Portable fundus camera image, image size 2212x1659.
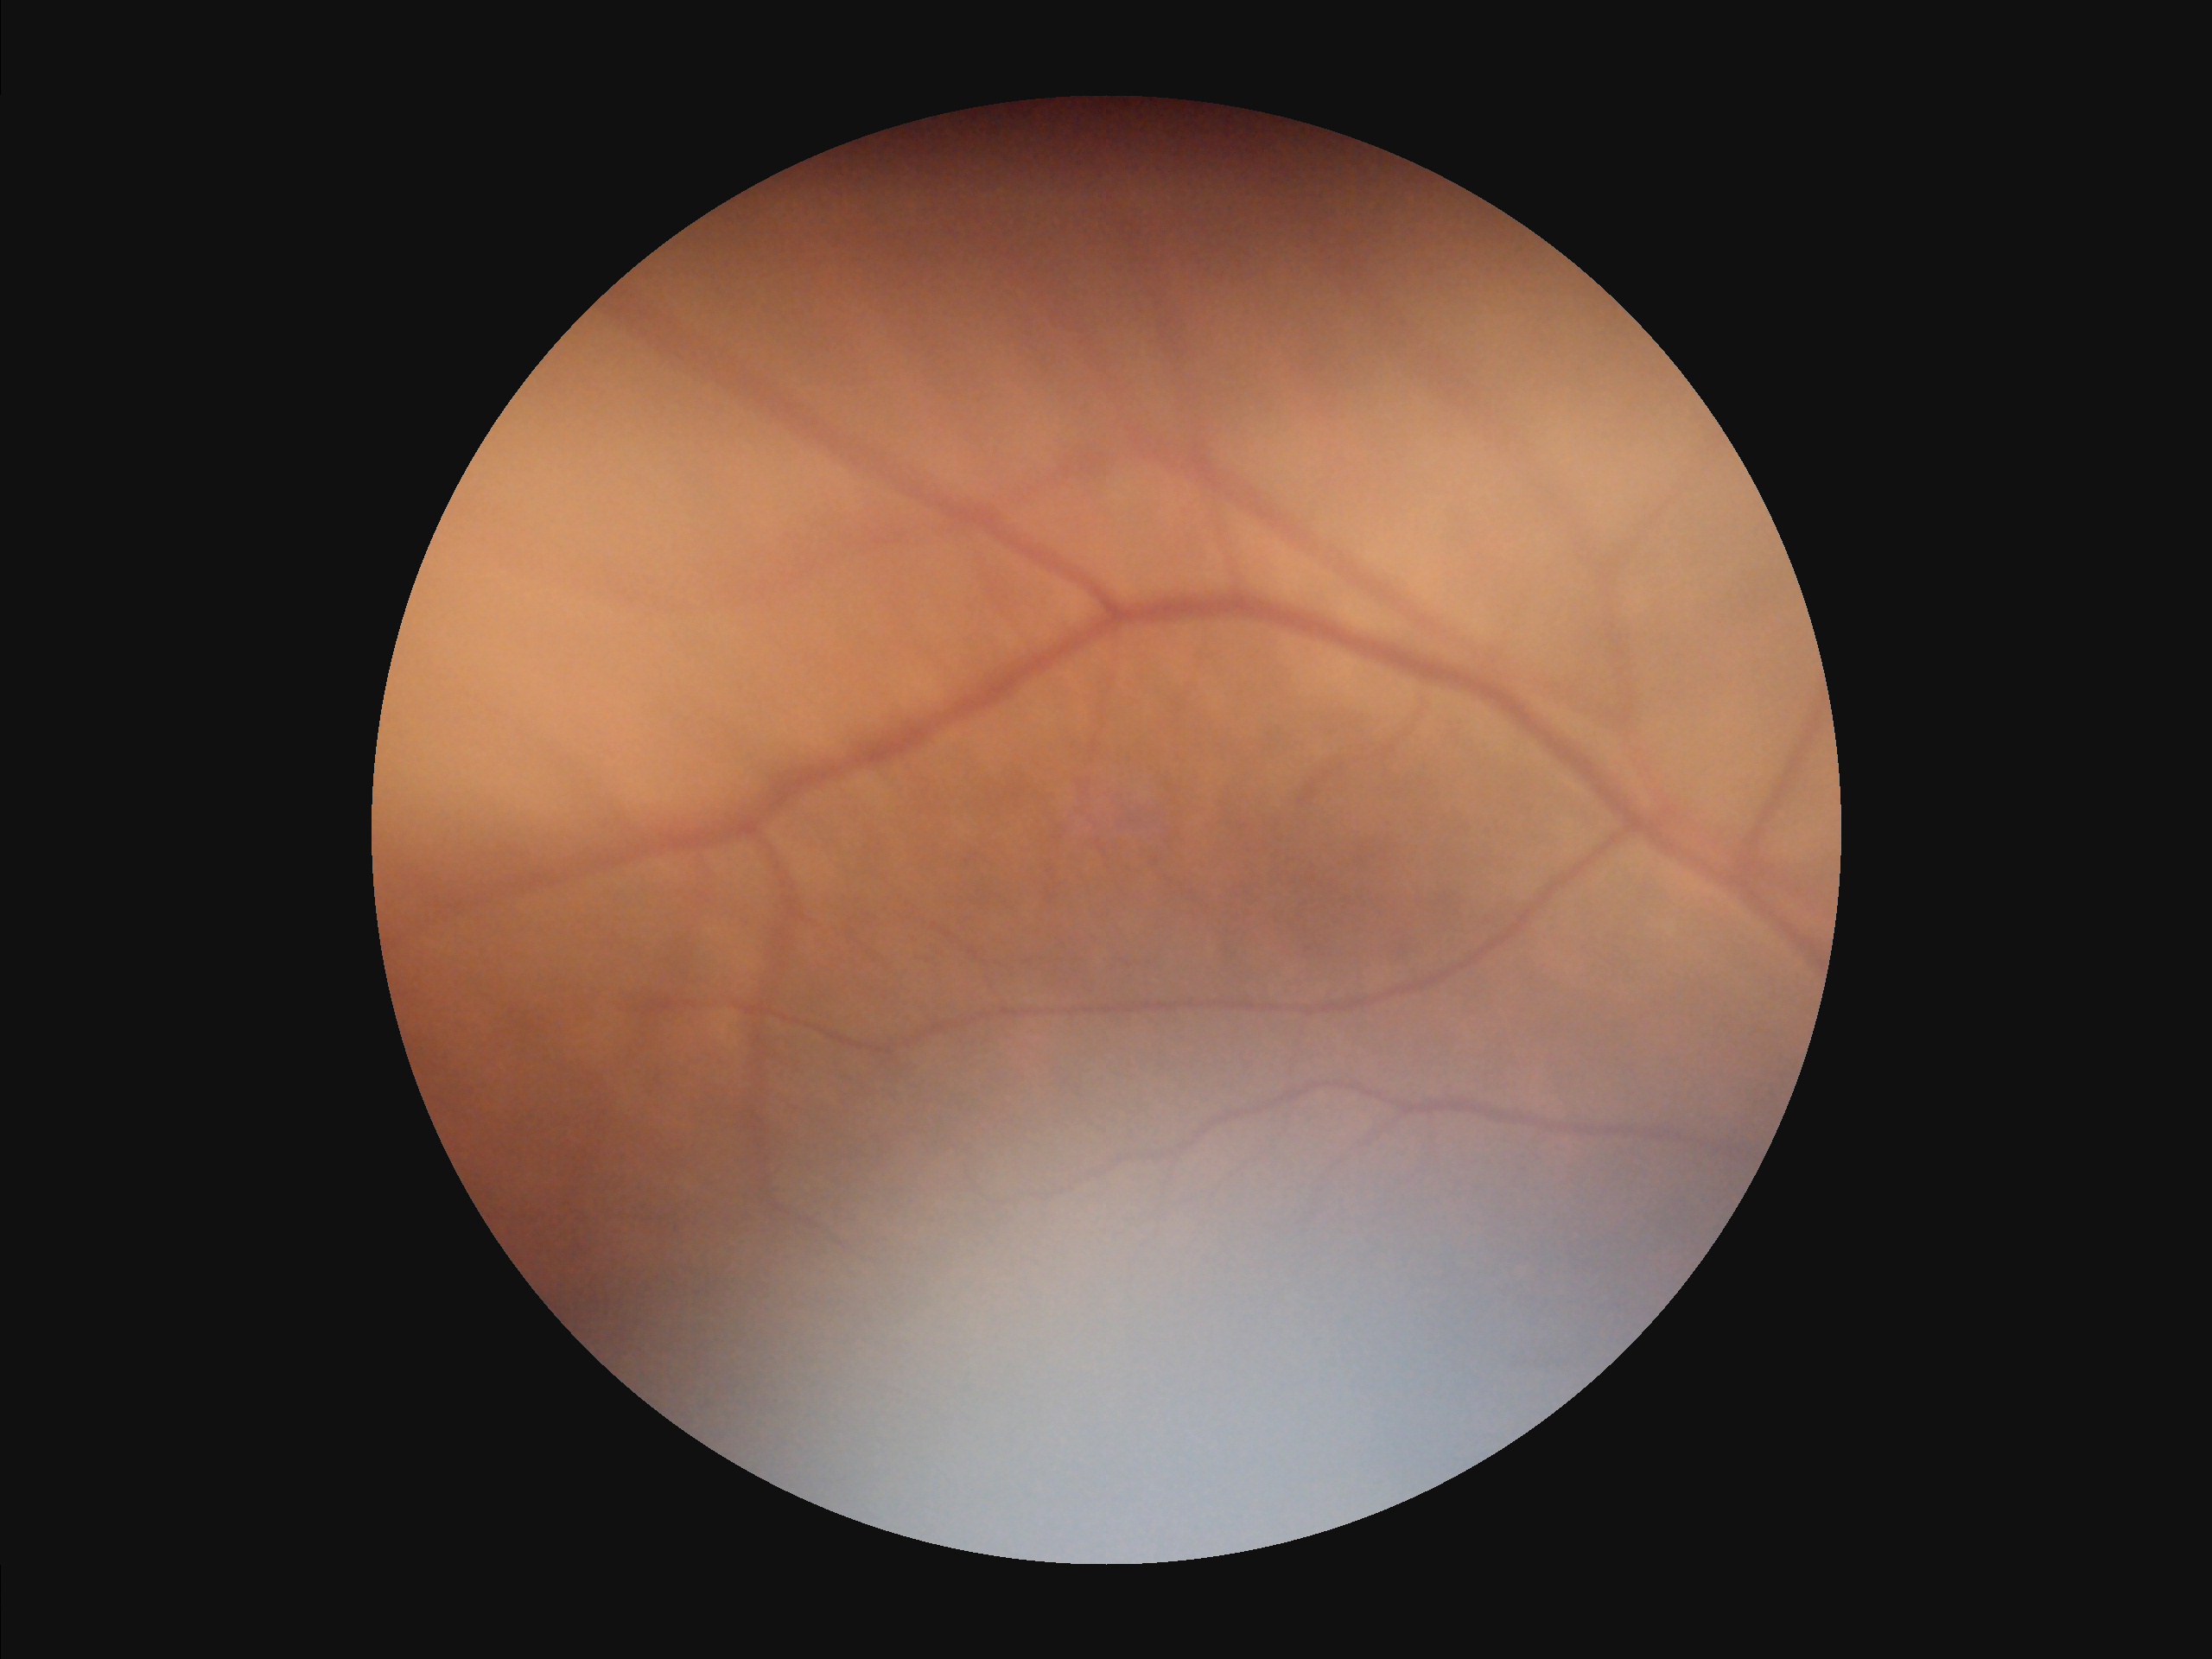

Image quality:
- clarity: reduced sharpness with visible blur
- overall: poor, ungradable
- illumination: inadequate, with uneven exposure or color distortion
- contrast: vessels and details readily distinguishable